240x240px · non-mydriatic:
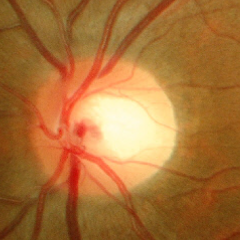 Glaucoma stage = no glaucomatous optic neuropathy.